Wide-field contact fundus photograph of an infant; captured with the Clarity RetCam 3 (130° field of view).
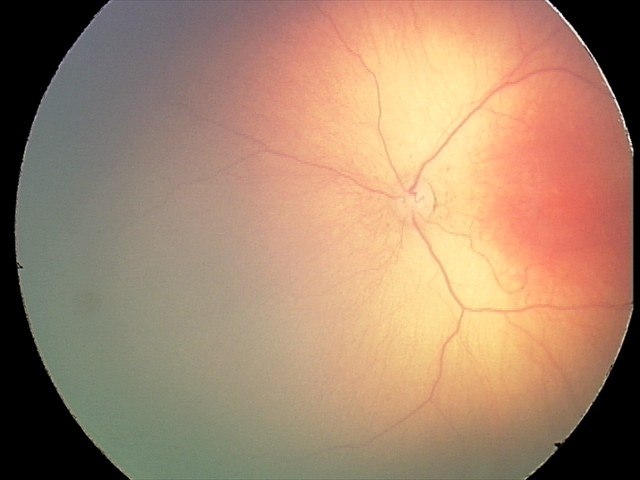

Examination diagnosed as retinopathy of prematurity (ROP) stage 2 — ridge with height and width at the demarcation line. No plus disease.